Fundus photo · 1924x1556px:
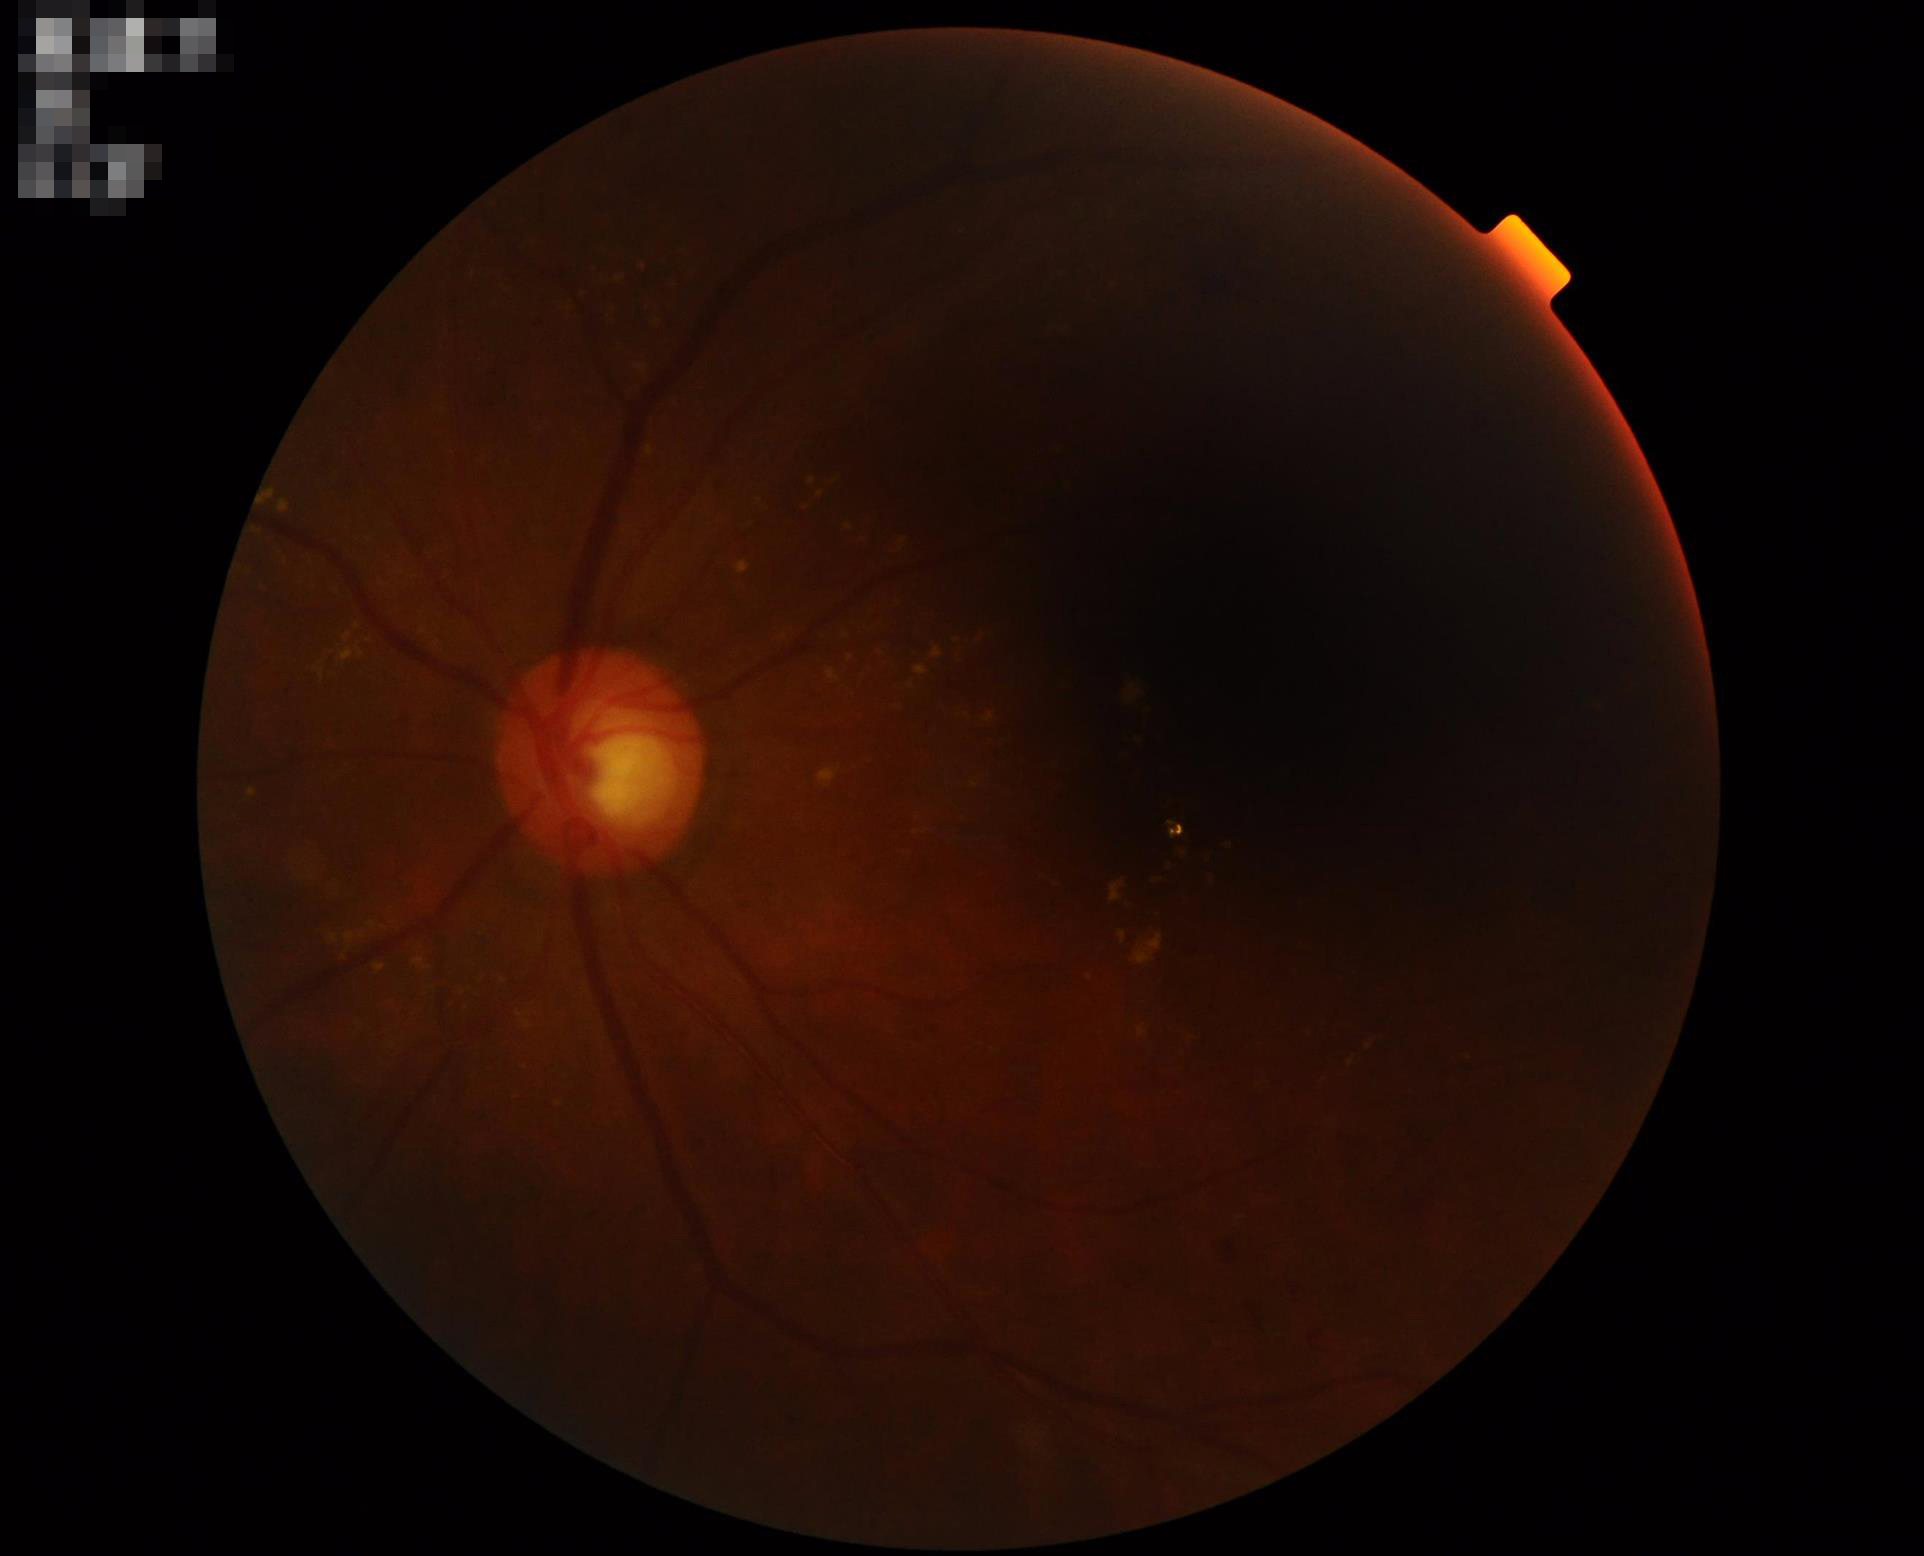 Illumination and color are suboptimal. Overall quality is poor; the image is difficult to grade. Vessels and details are readily distinguishable.